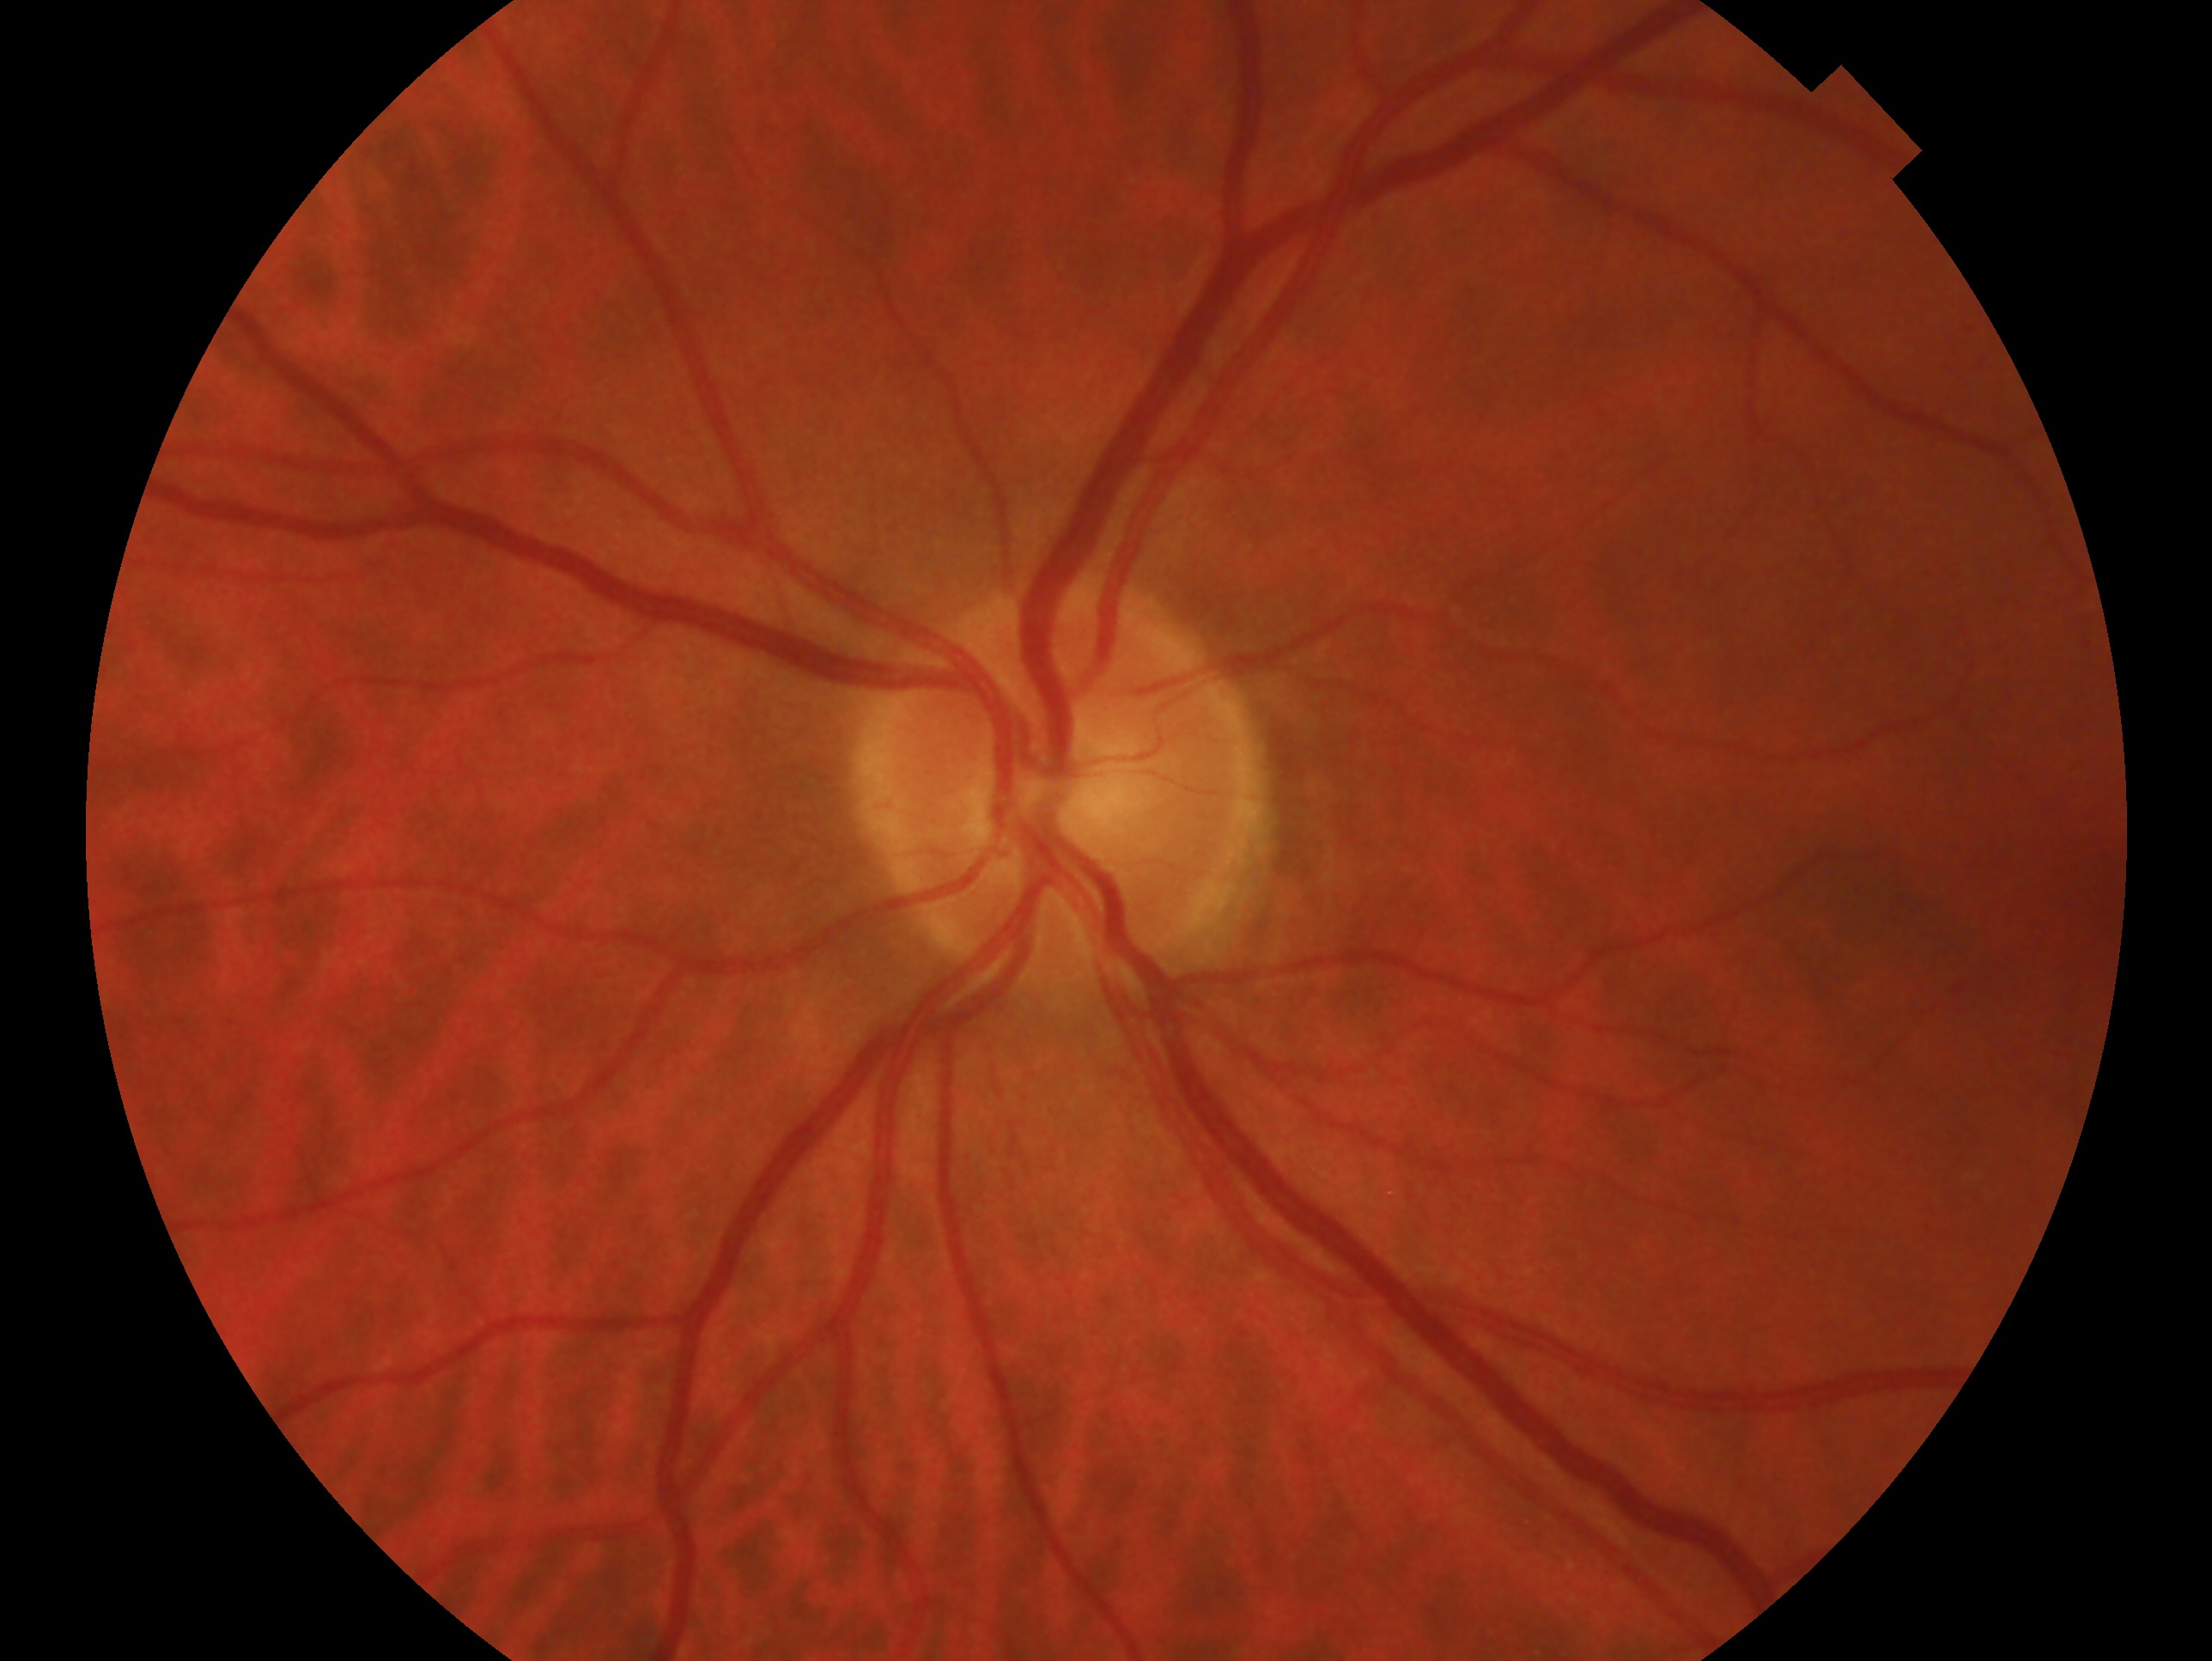

The image shows the OS.
Glaucoma diagnosis — possible glaucoma.